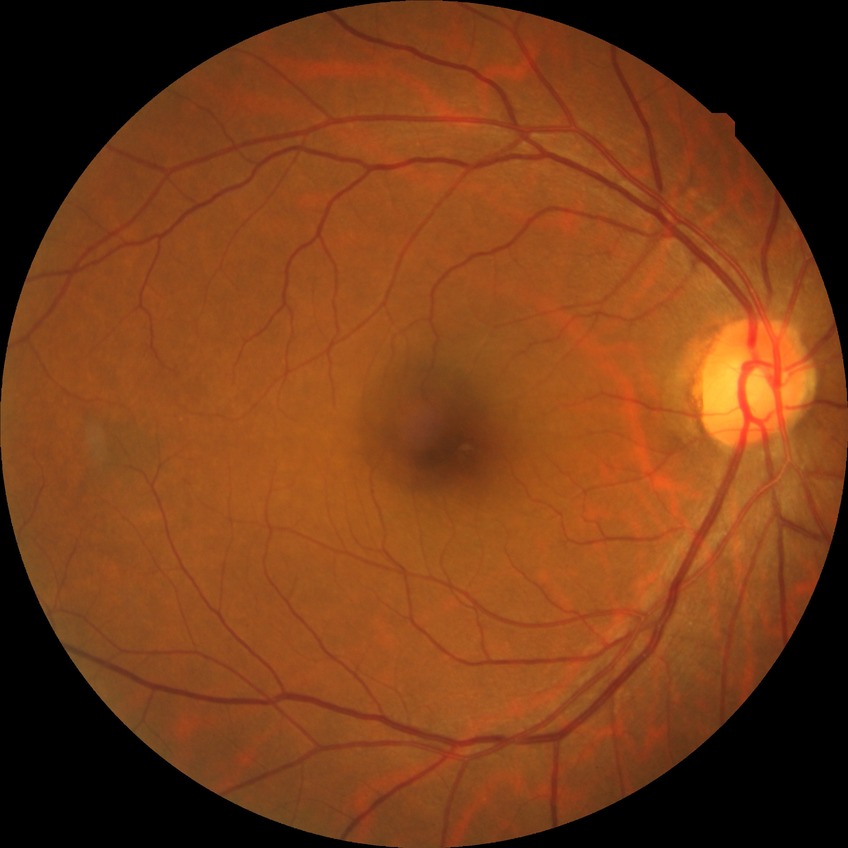

Davis grade is NDR.